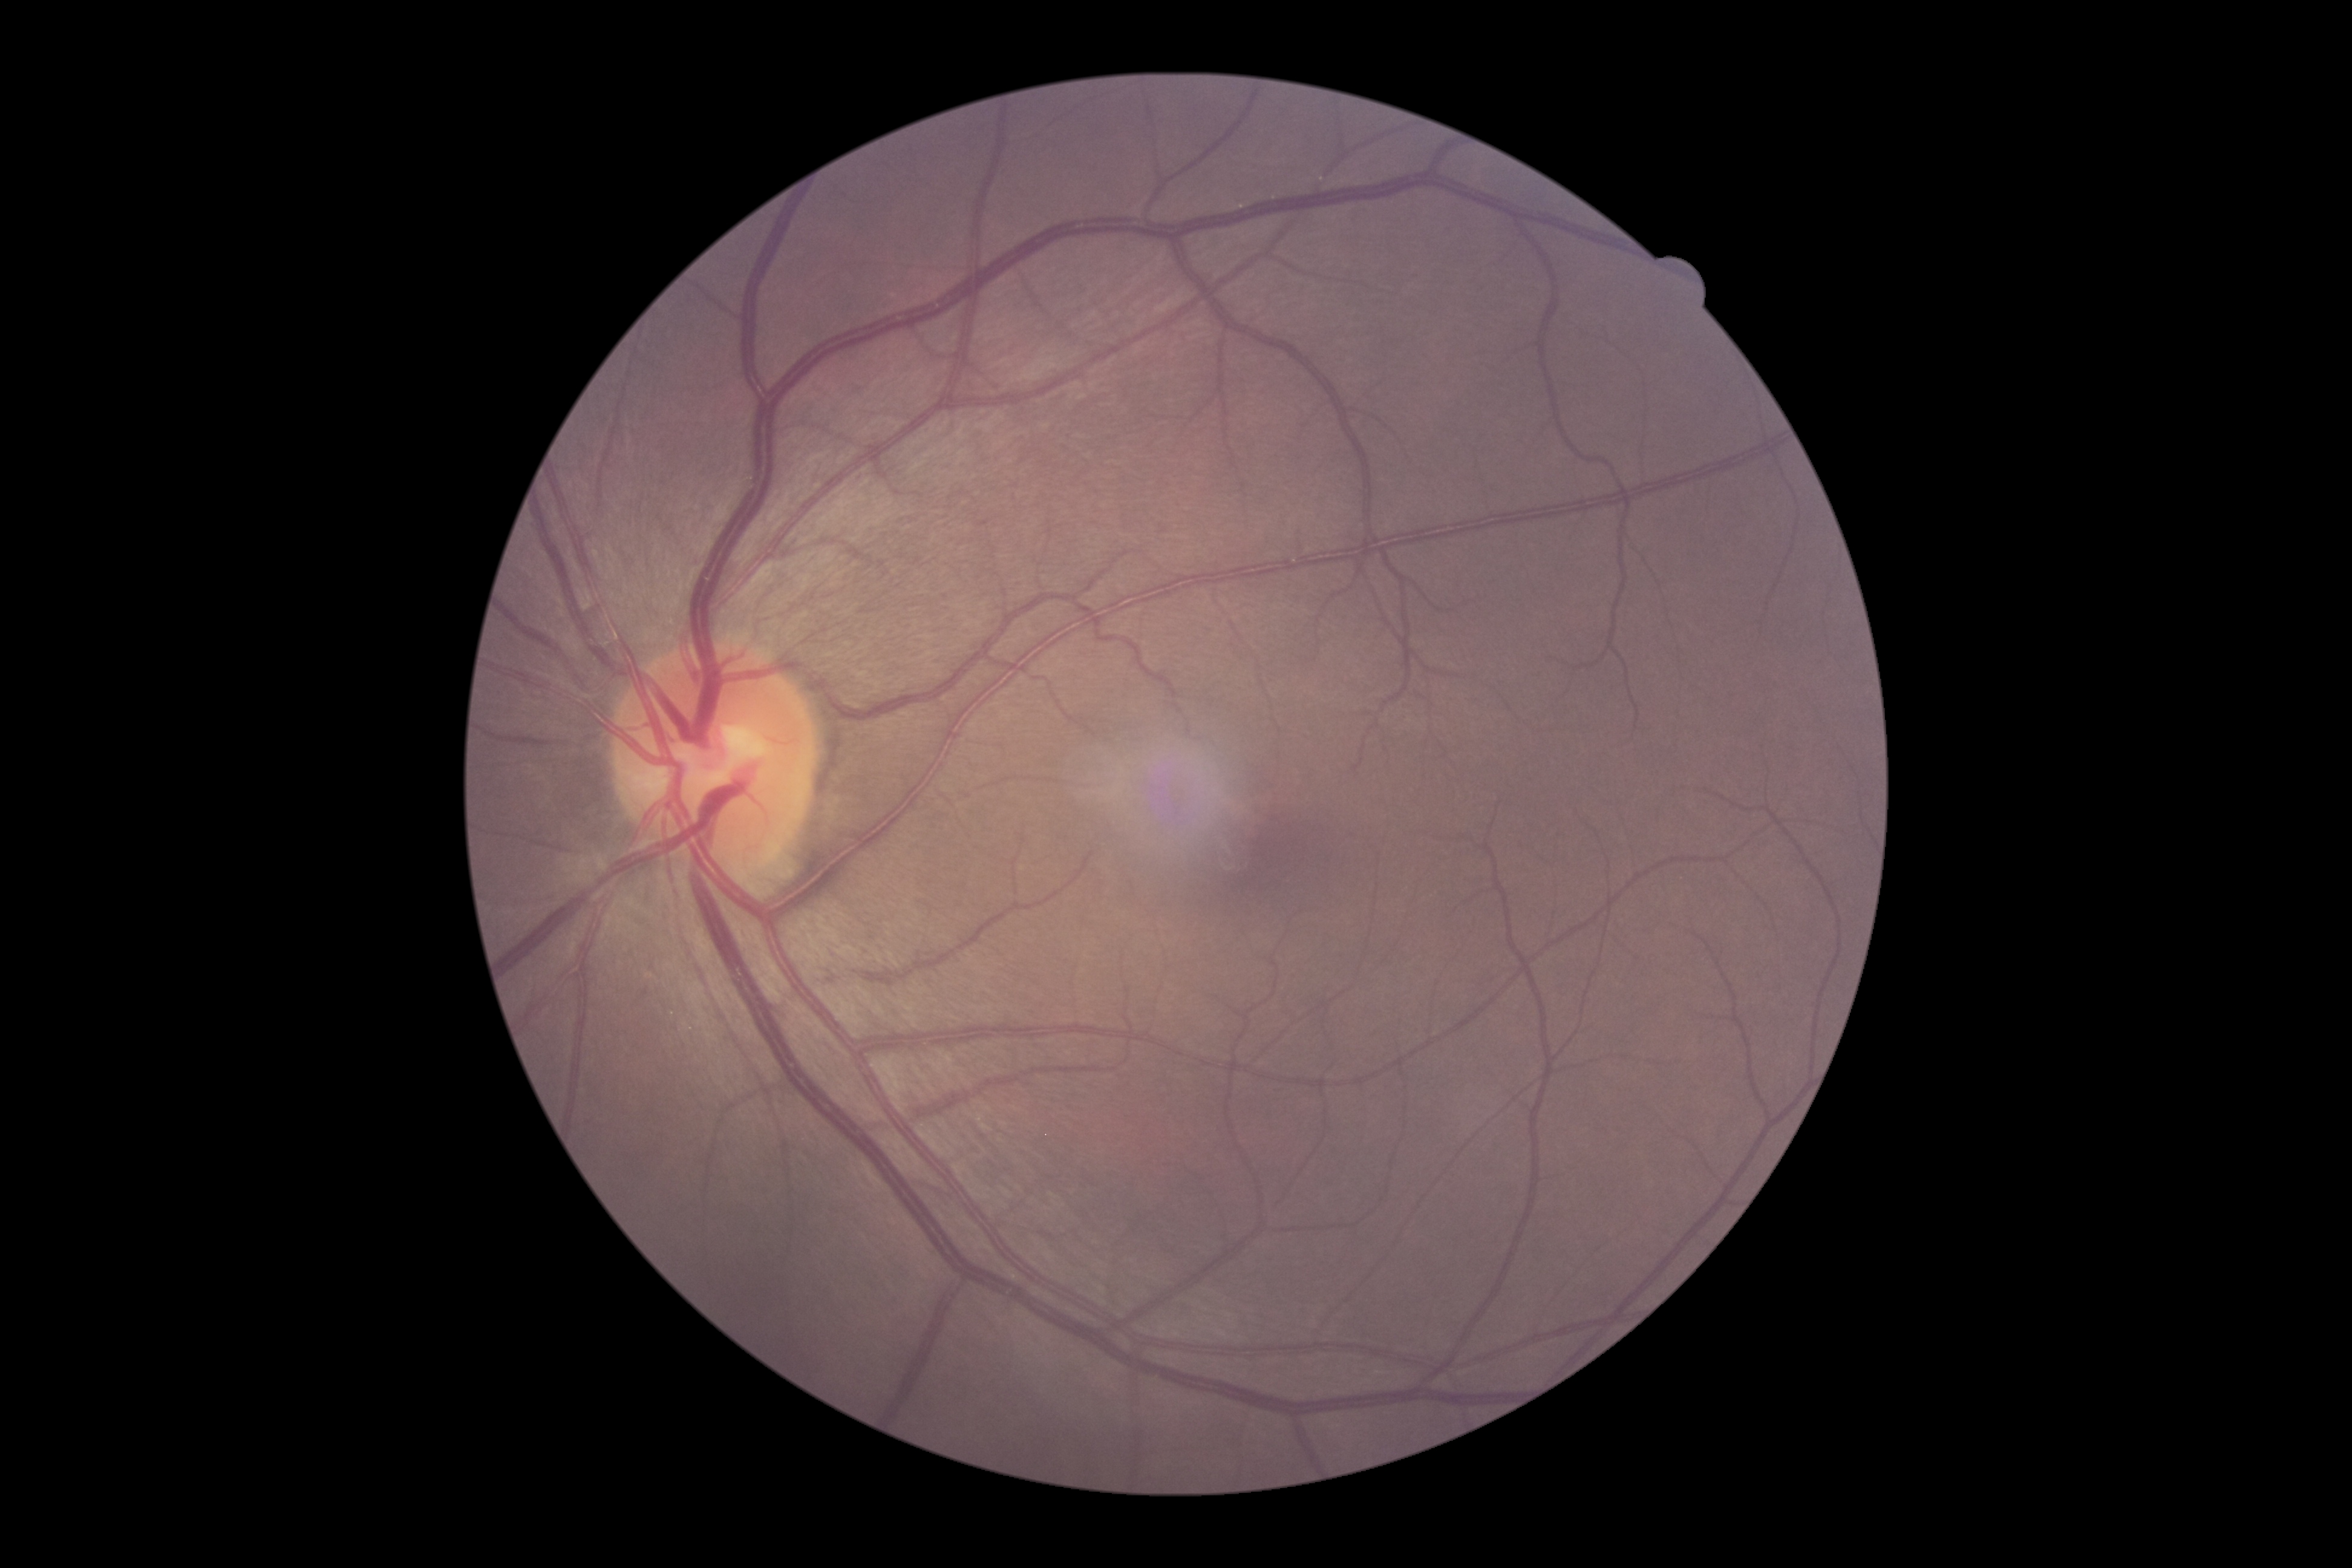
DR impression: no apparent DR, DR stage: grade 0.